Acquired with a NIDEK AFC-230; nonmydriatic; 45° field of view — 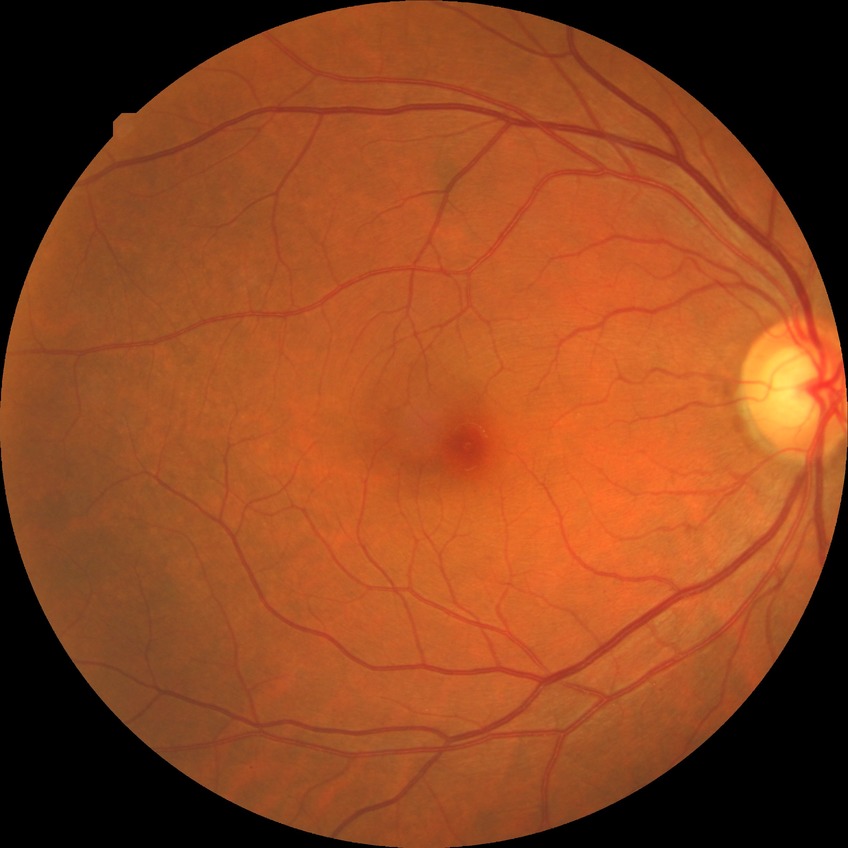

Modified Davis grading is simple diabetic retinopathy.